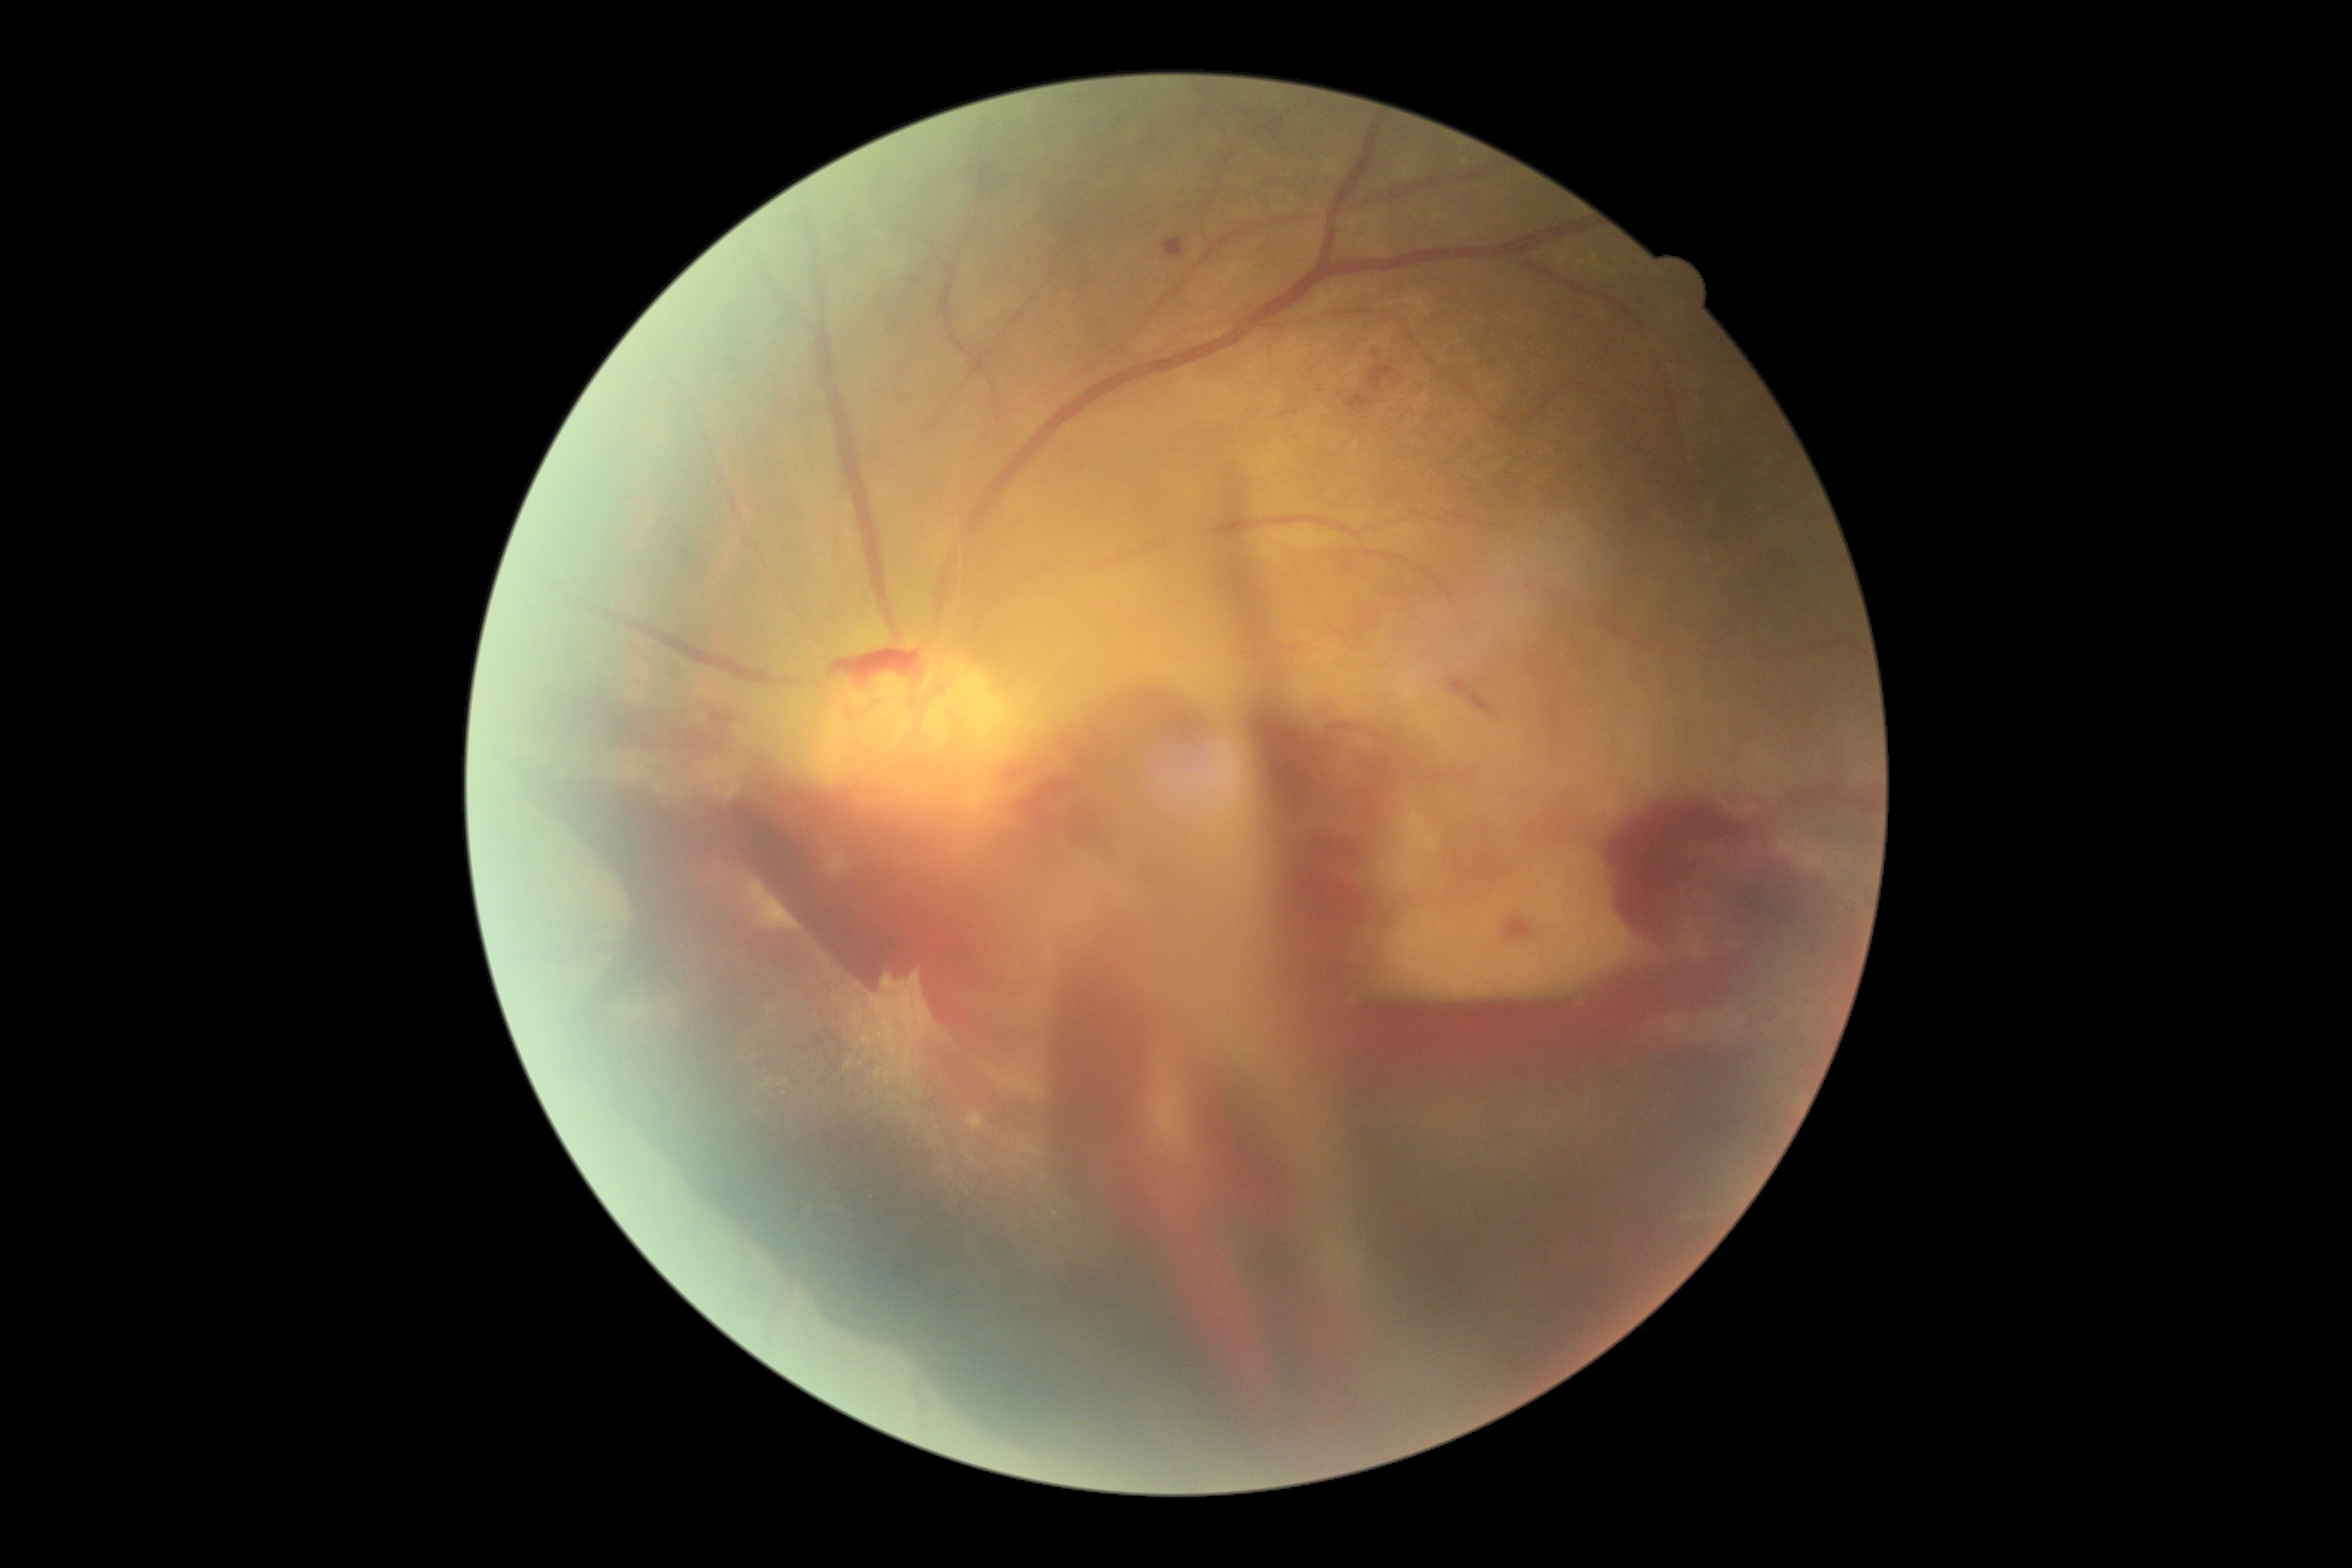 Findings:
* DR — grade 4